2048 x 1536 pixels
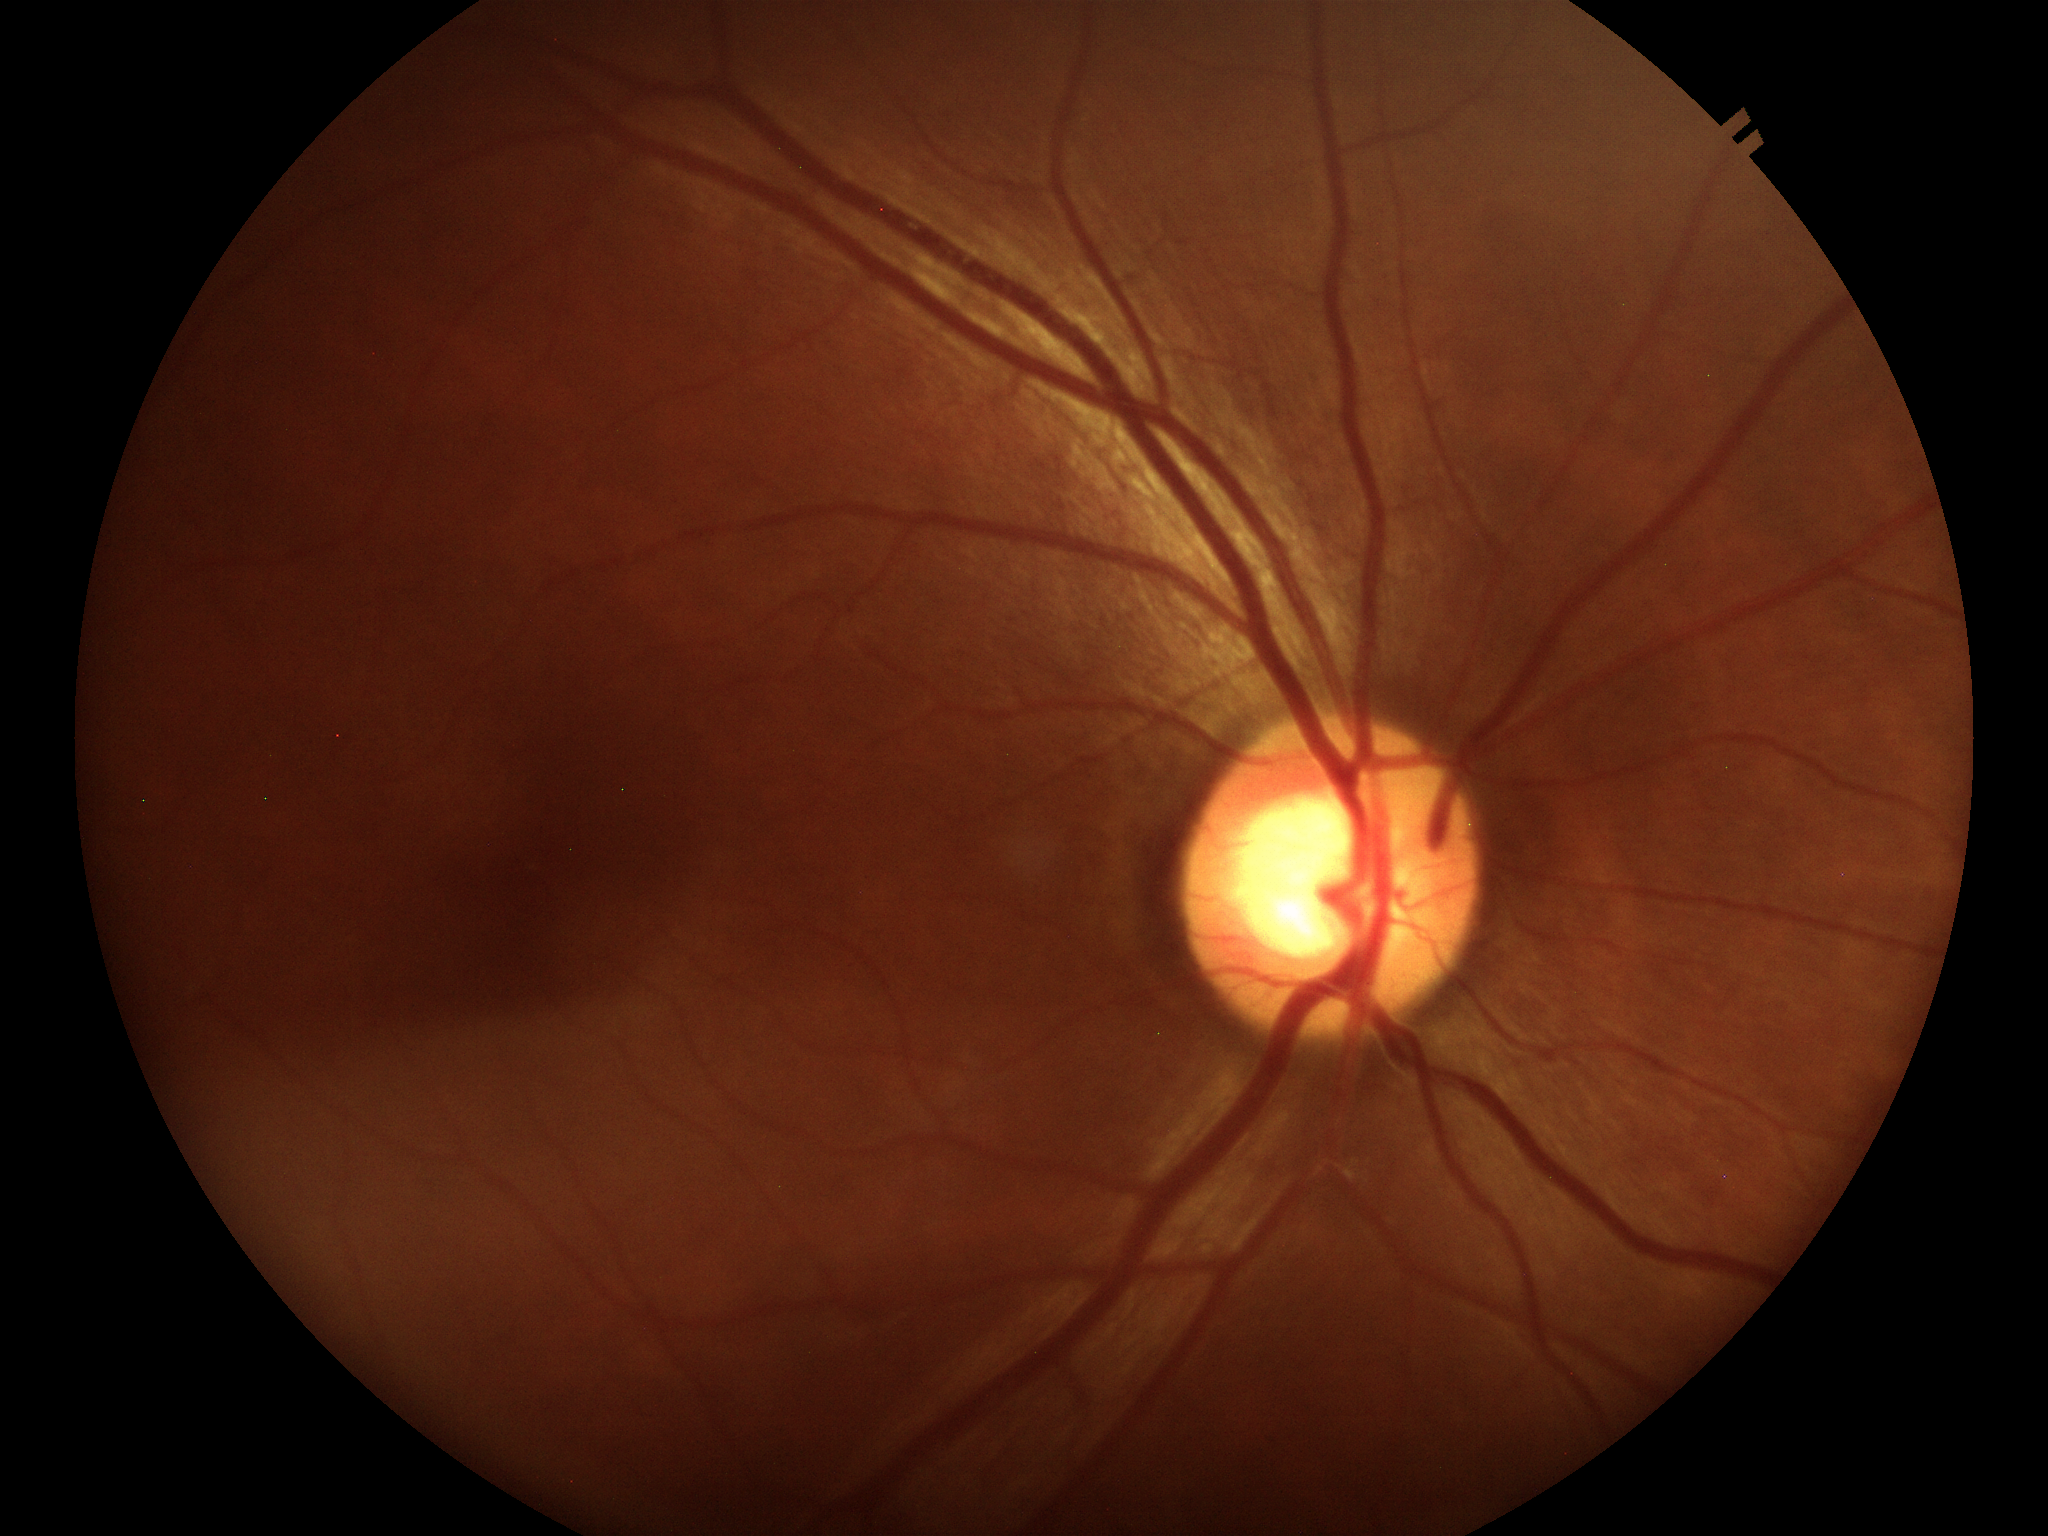
Glaucoma decision=no suspicious findings | vertical CDR=0.54 | area cup-disc ratio=0.34 | horizontal CDR=0.61